Graded on the modified Davis scale · NIDEK AFC-230 · 45° FOV · nonmydriatic · 848 x 848 pixels · posterior pole color fundus photograph:
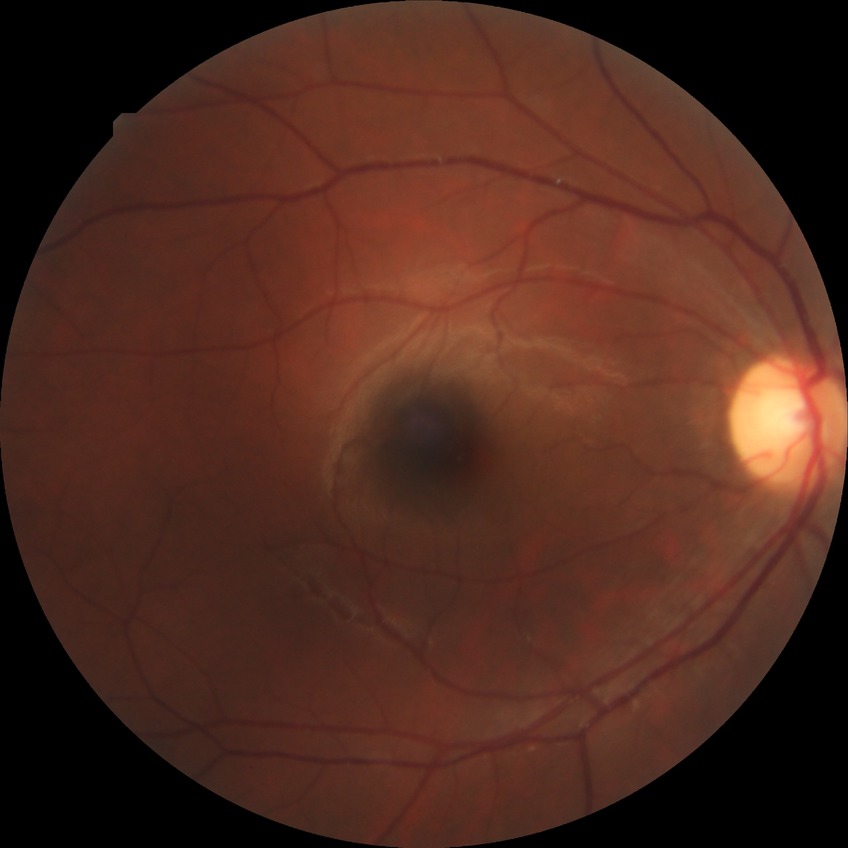
  davis_grade: no diabetic retinopathy